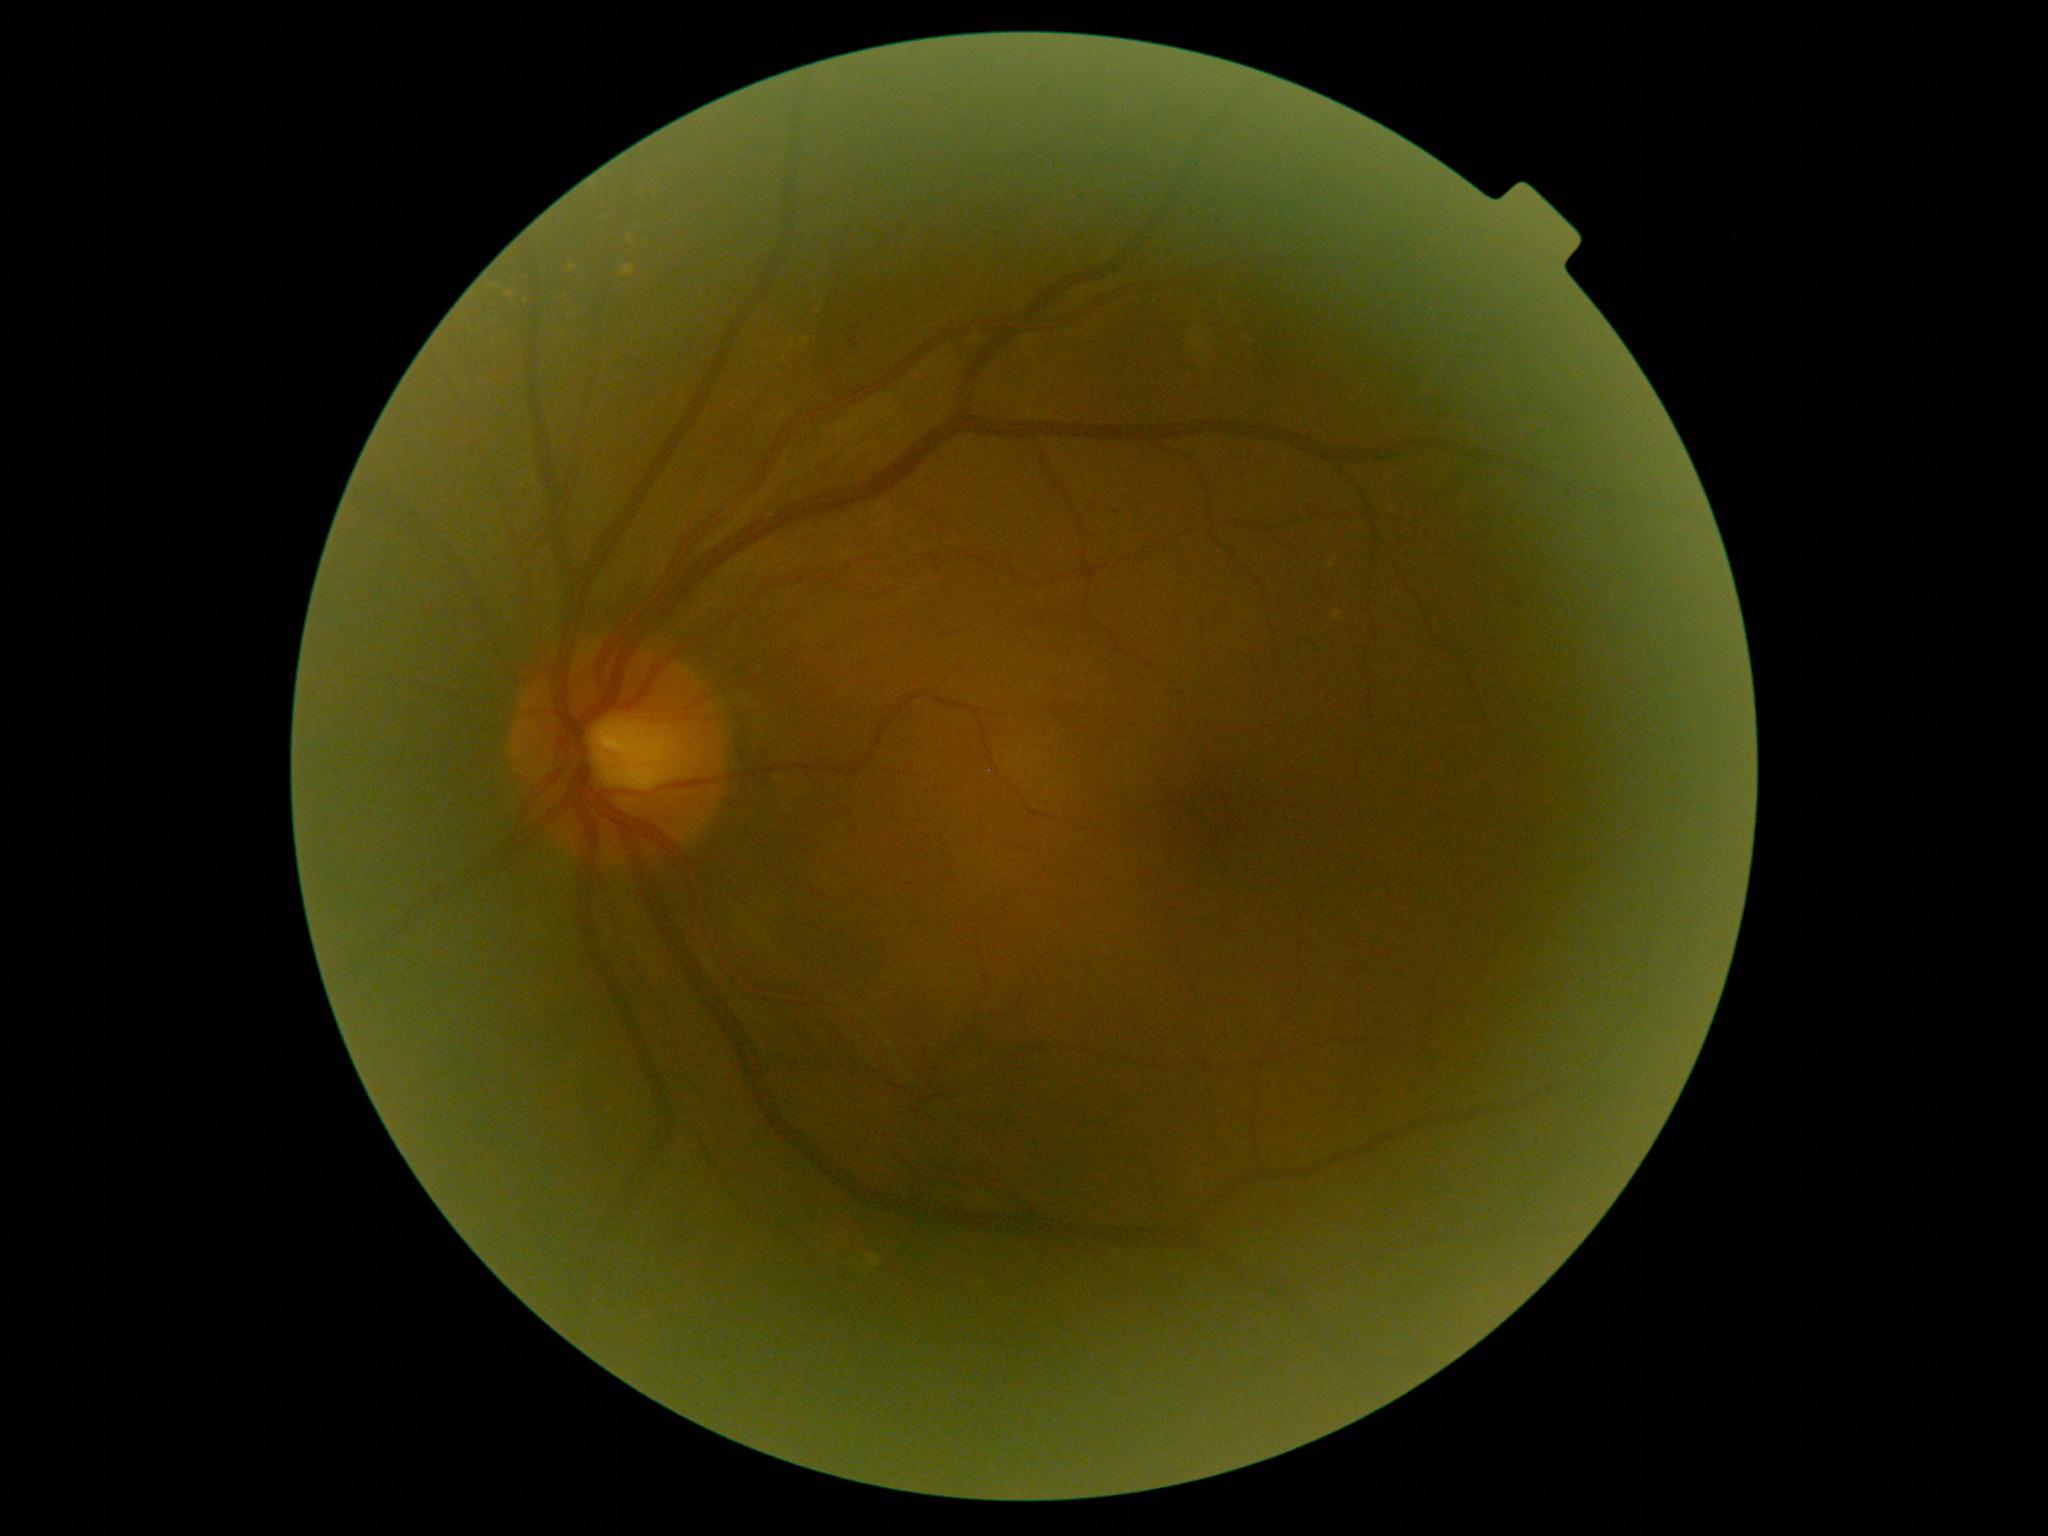
DR severity: moderate non-proliferative diabetic retinopathy (grade 2).